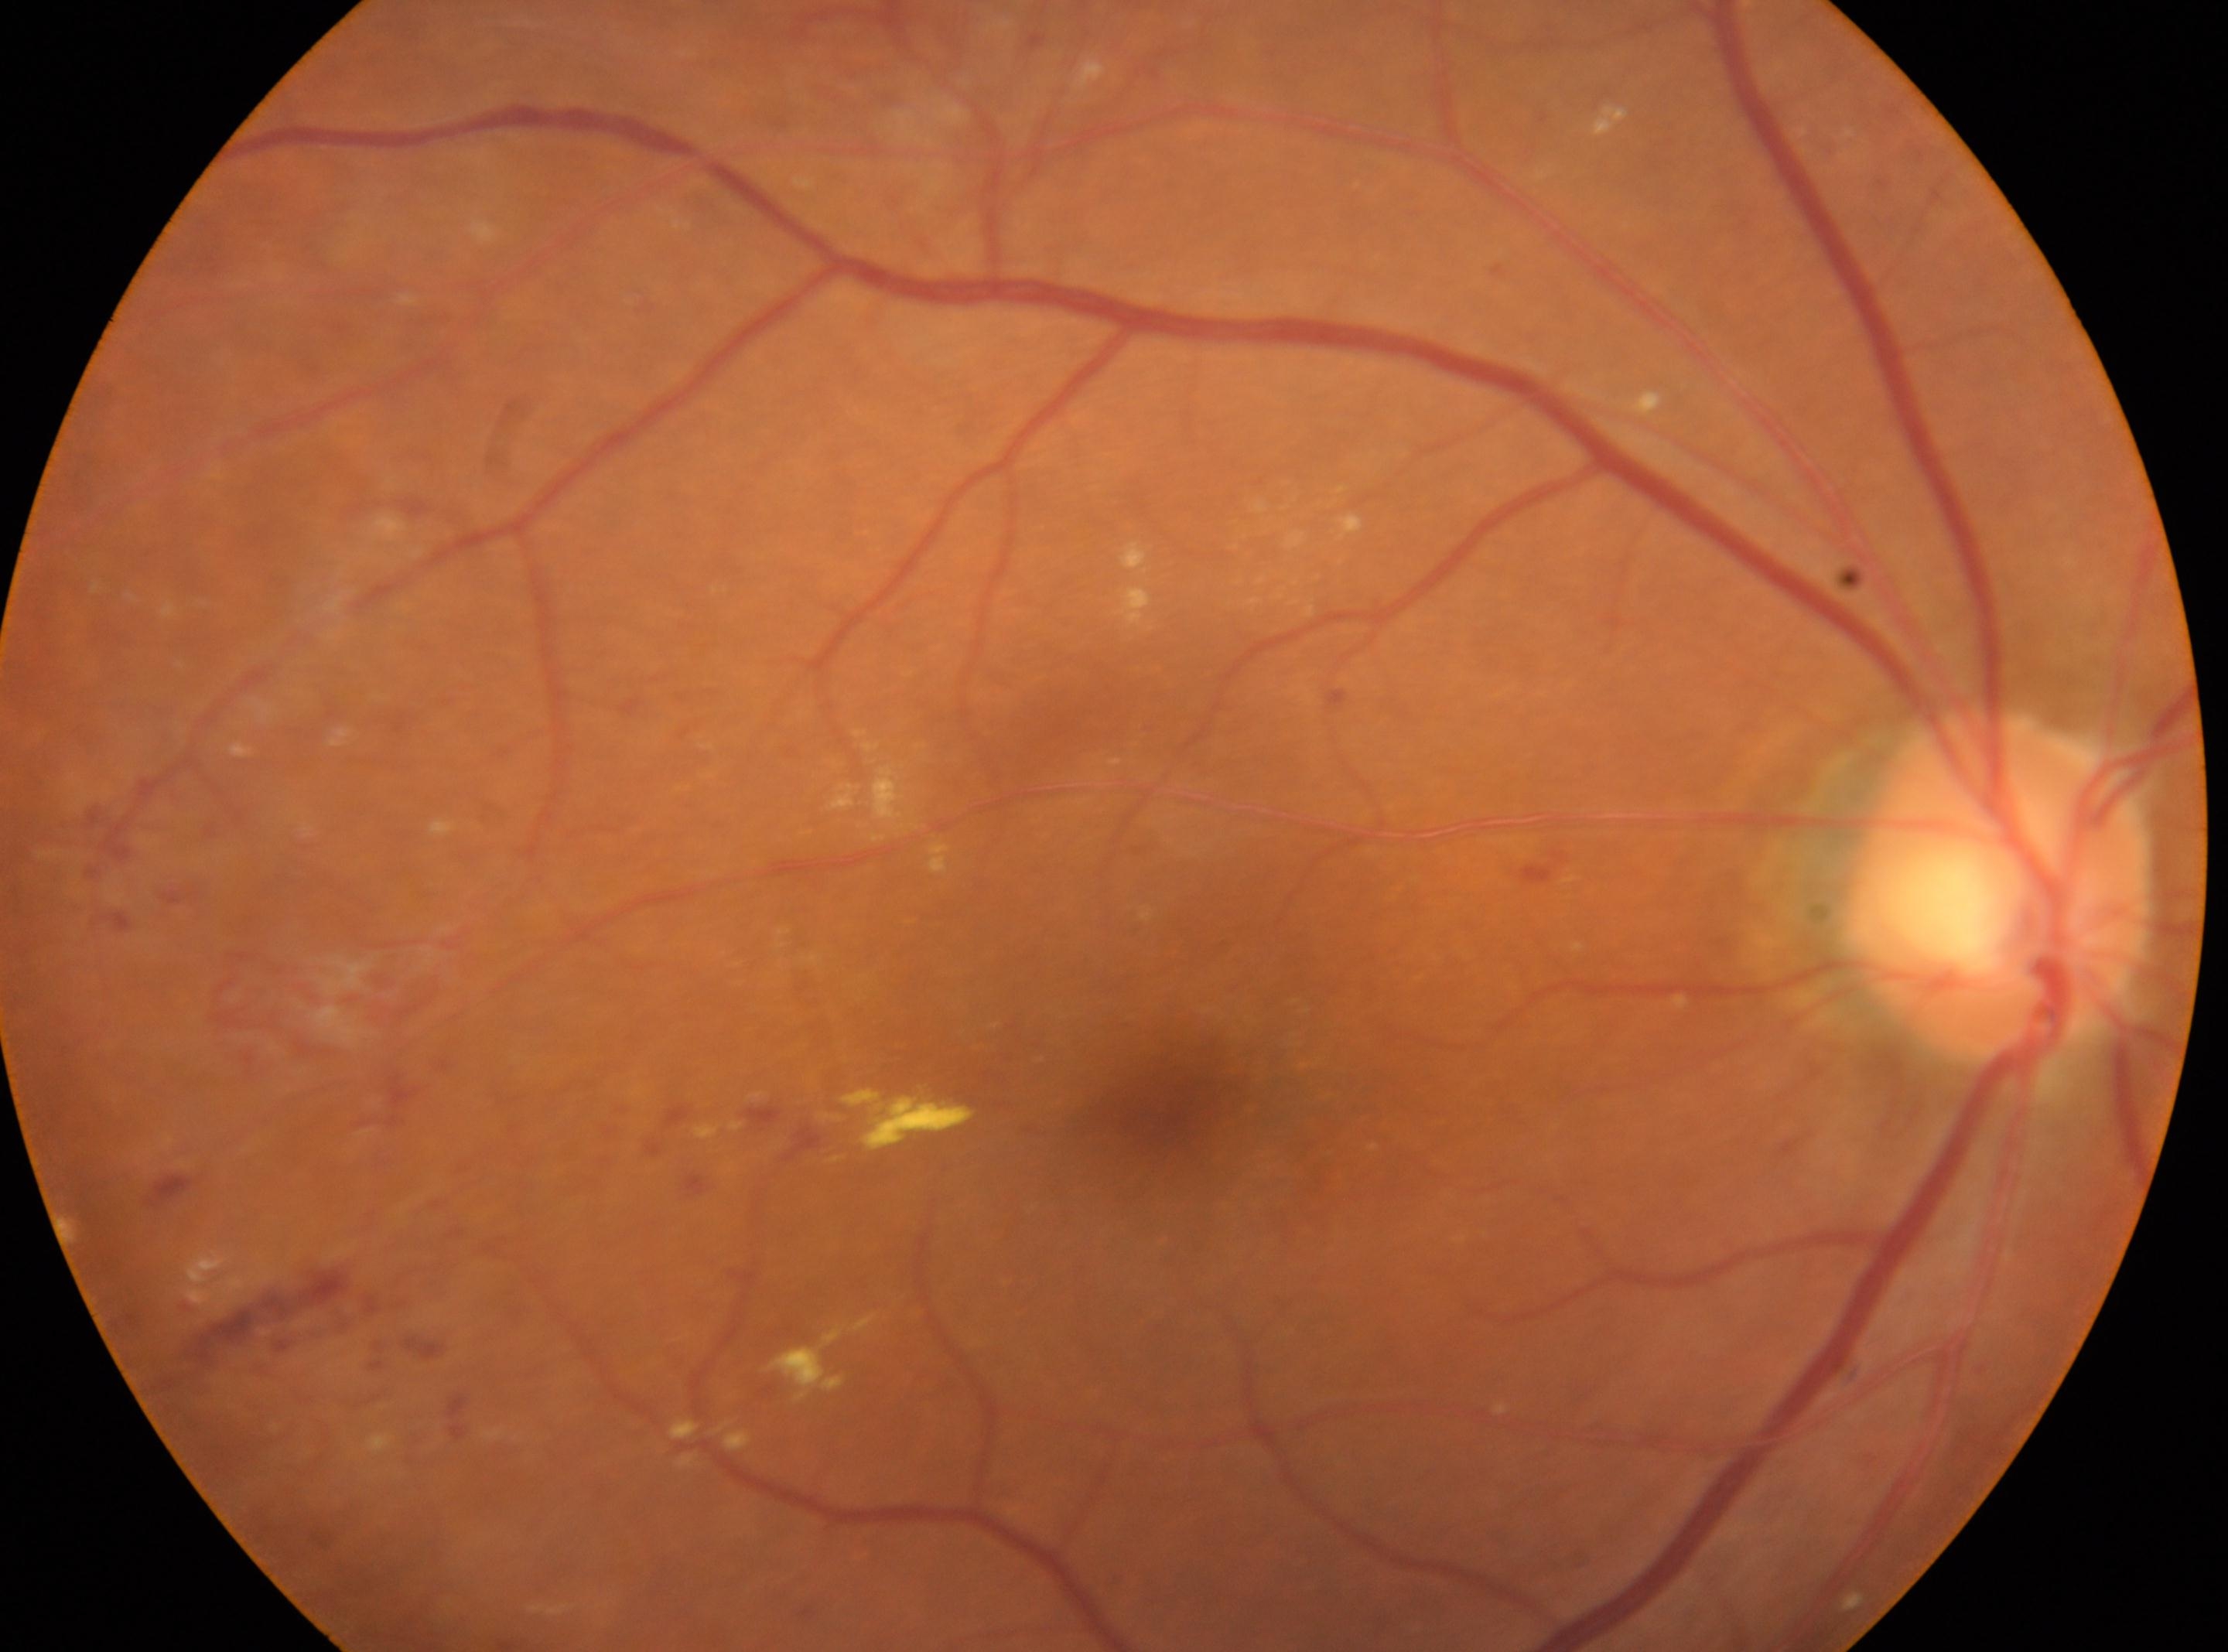

eye: OD | fovea centralis: 1160px, 1087px | diabetic retinopathy severity: grade 2 (moderate NPDR) | optic disc: 1997px, 889px.